Infant wide-field fundus photograph.
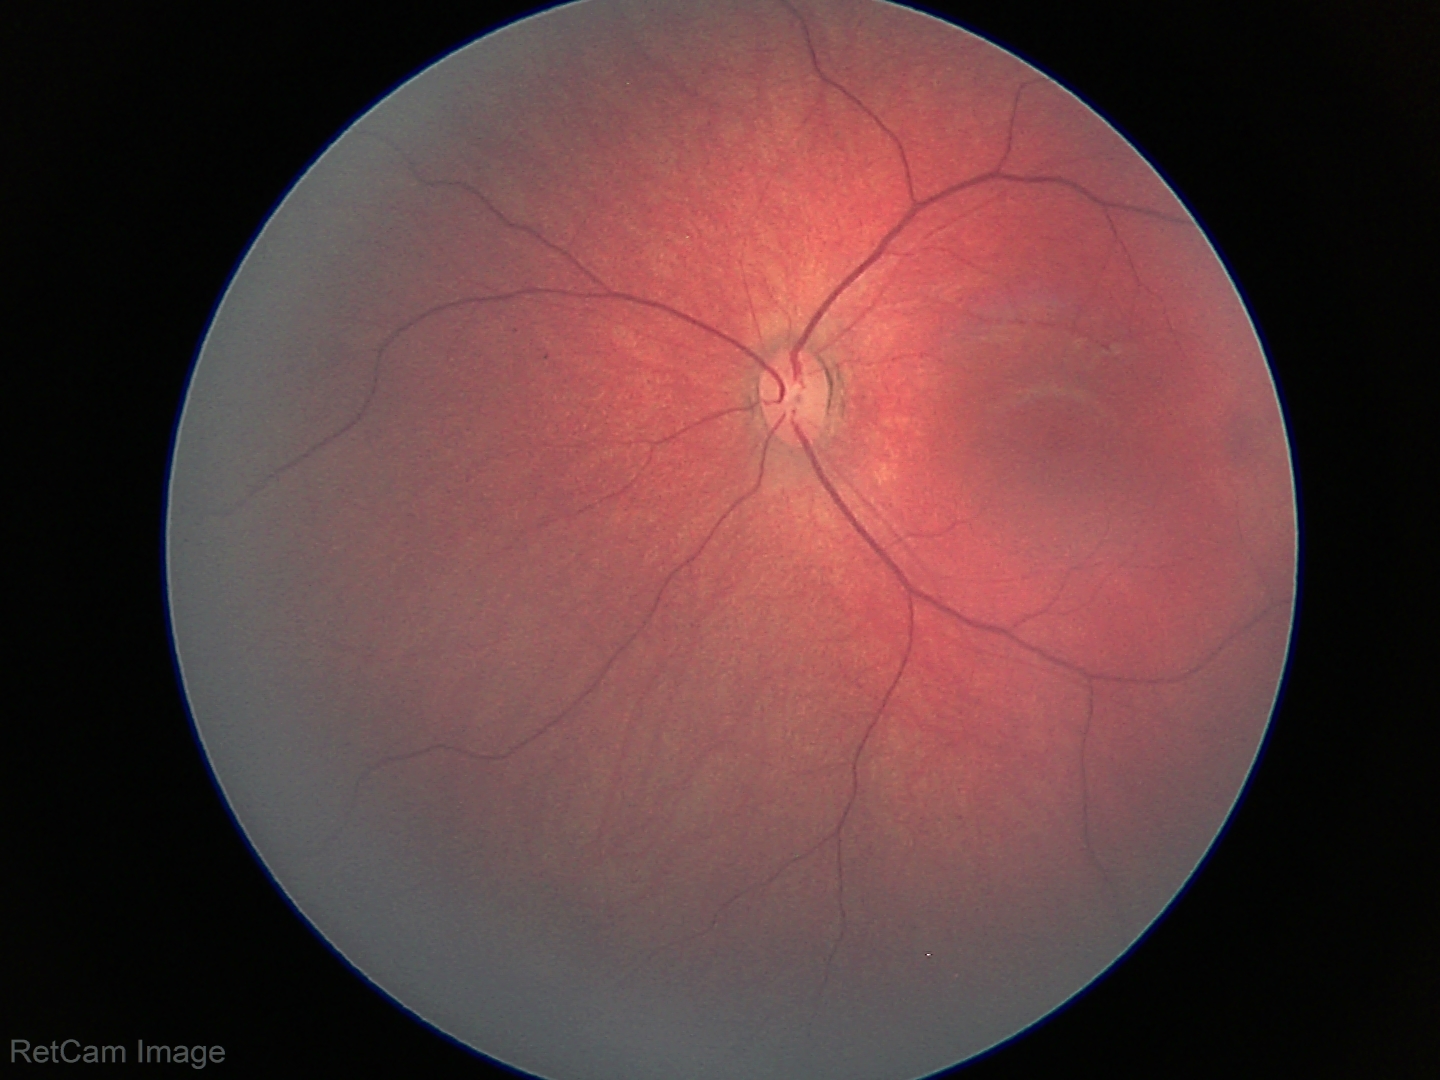

Physiological retinal appearance for postconceptual age.